Phoenix ICON wide-field infant fundus image; captured with the Phoenix ICON (100° field of view):
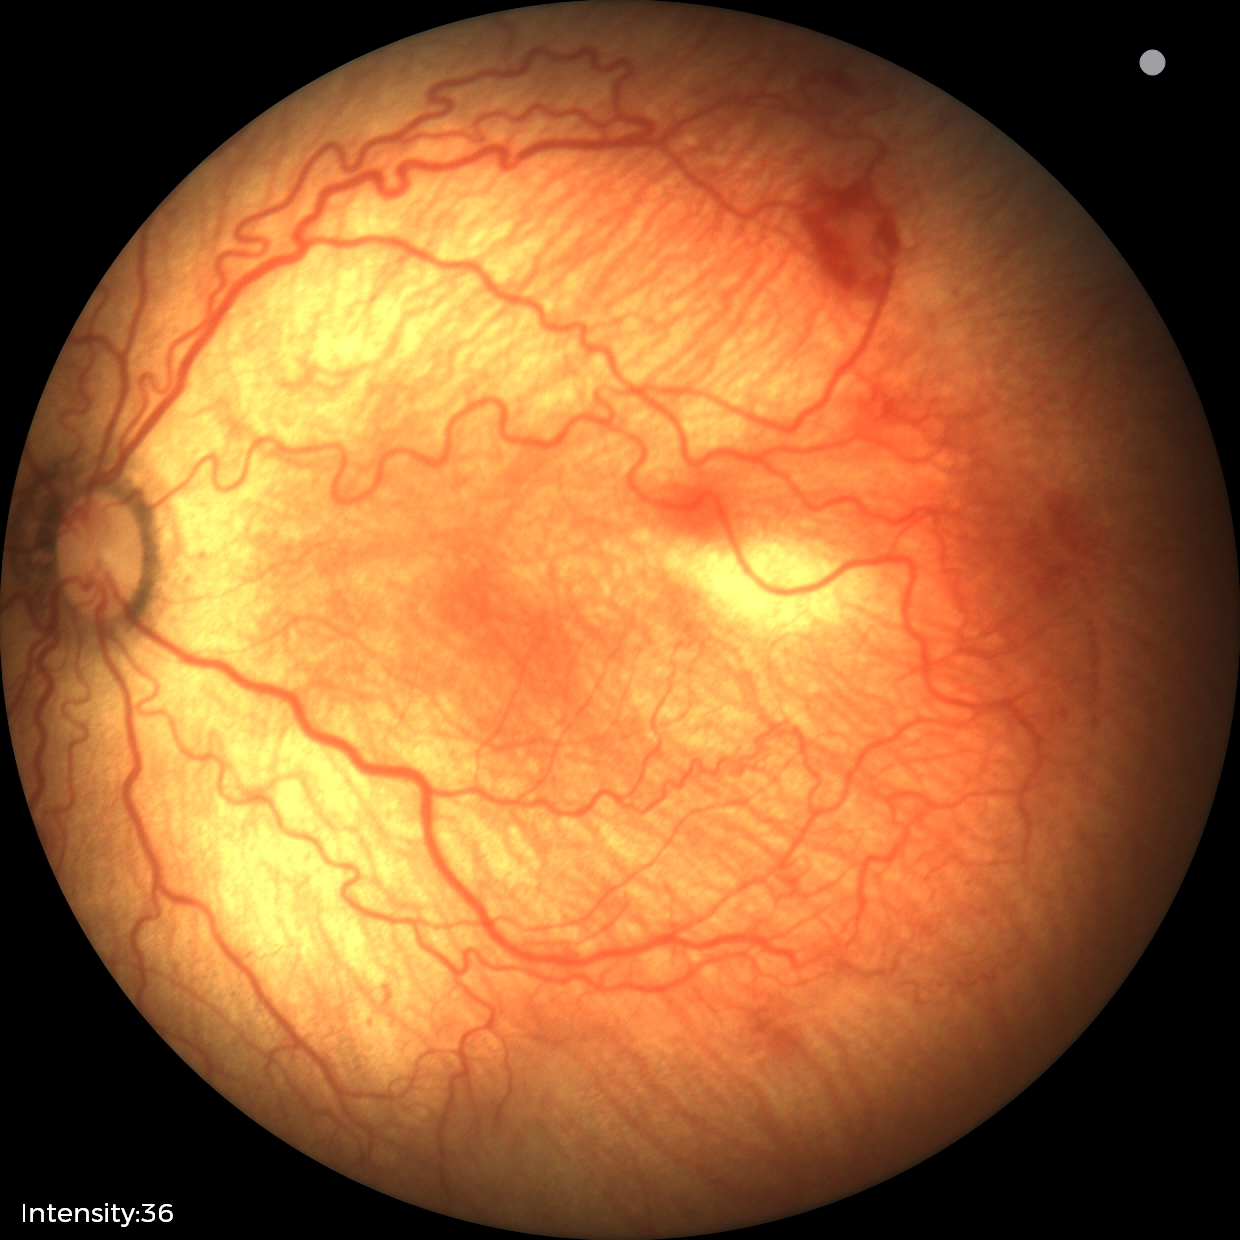

Plus disease present.
Examination diagnosed as retinopathy of prematurity (ROP) stage 2.